1240 x 1240 pixels; wide-field fundus photograph of an infant; Phoenix ICON, 100° FOV
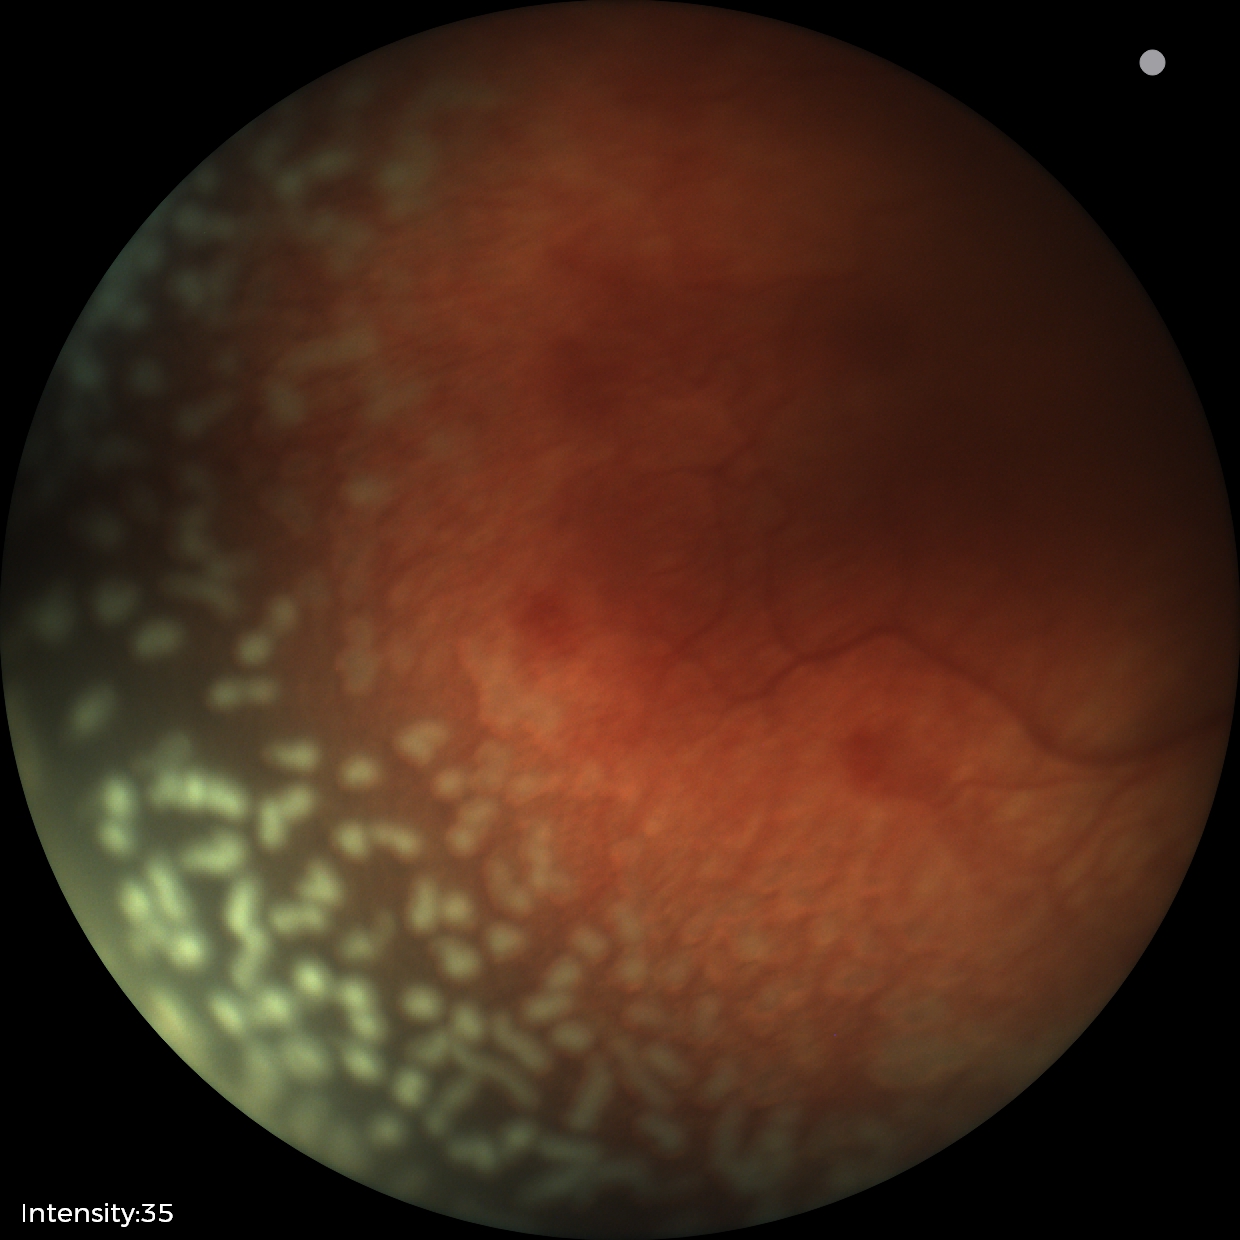
With plus disease.
Diagnosis from this screening exam: ROP stage 2.